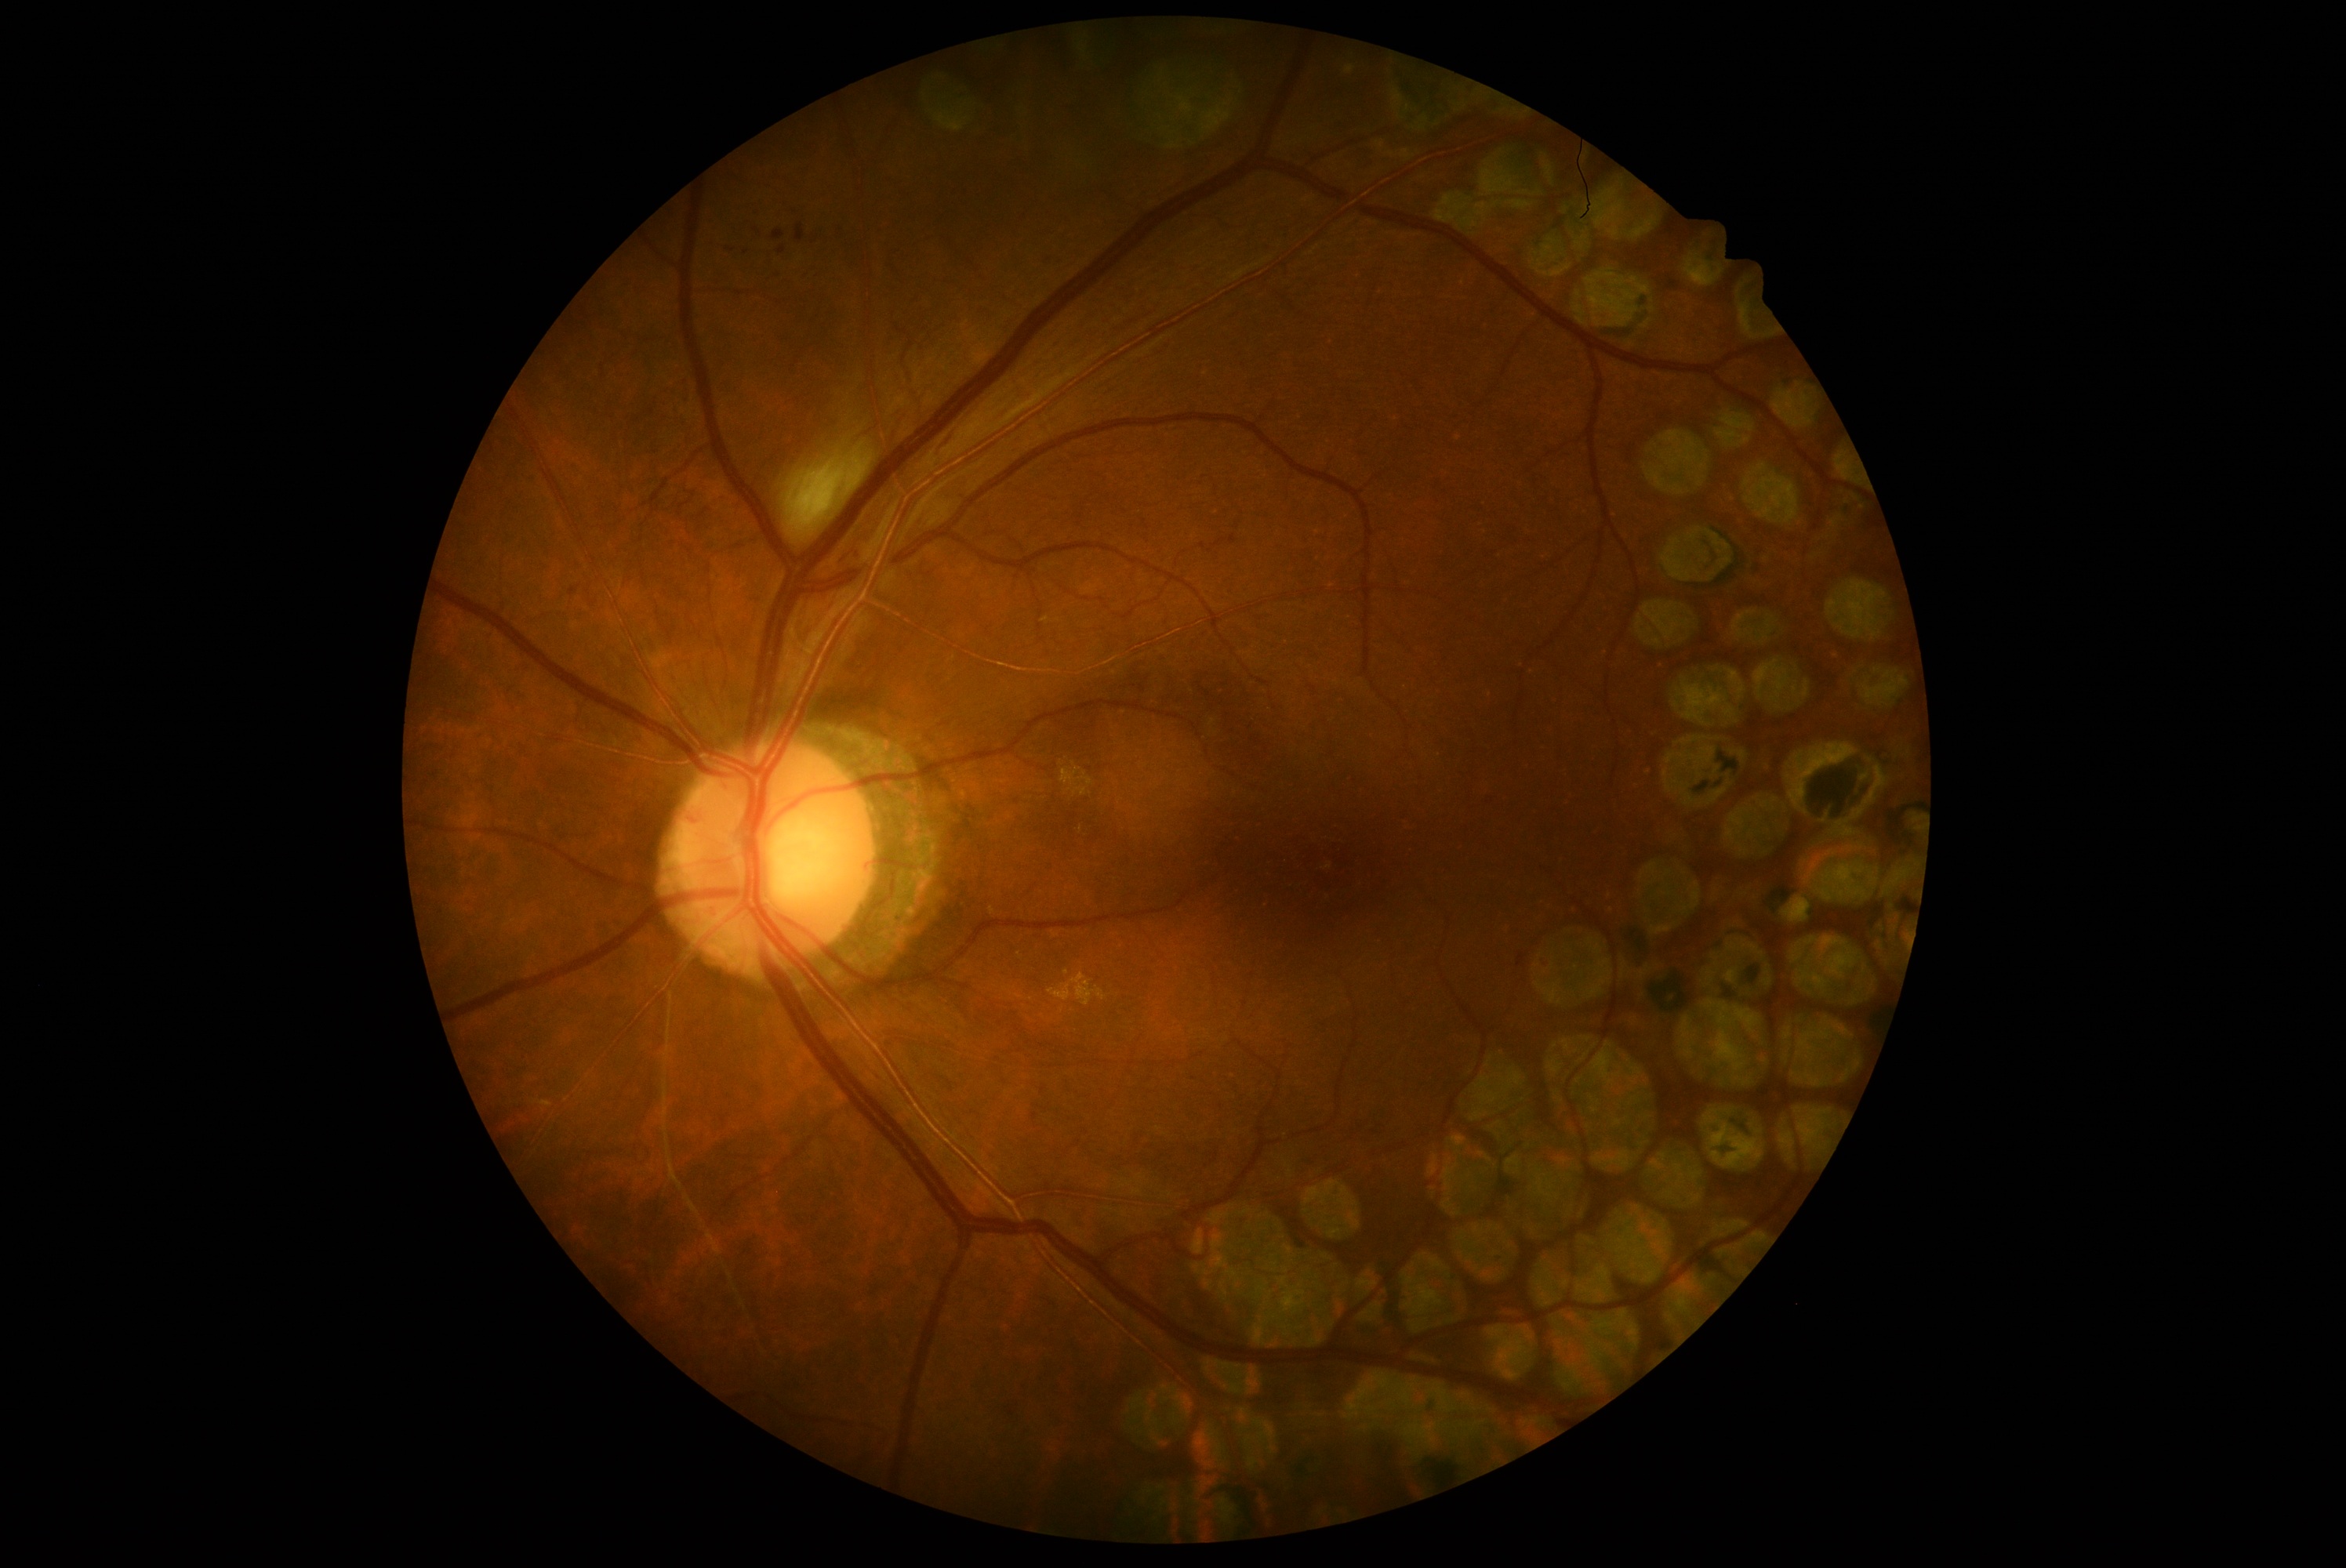

retinopathy grade = 2 (moderate NPDR).